Camera: Topcon TRC-NW8
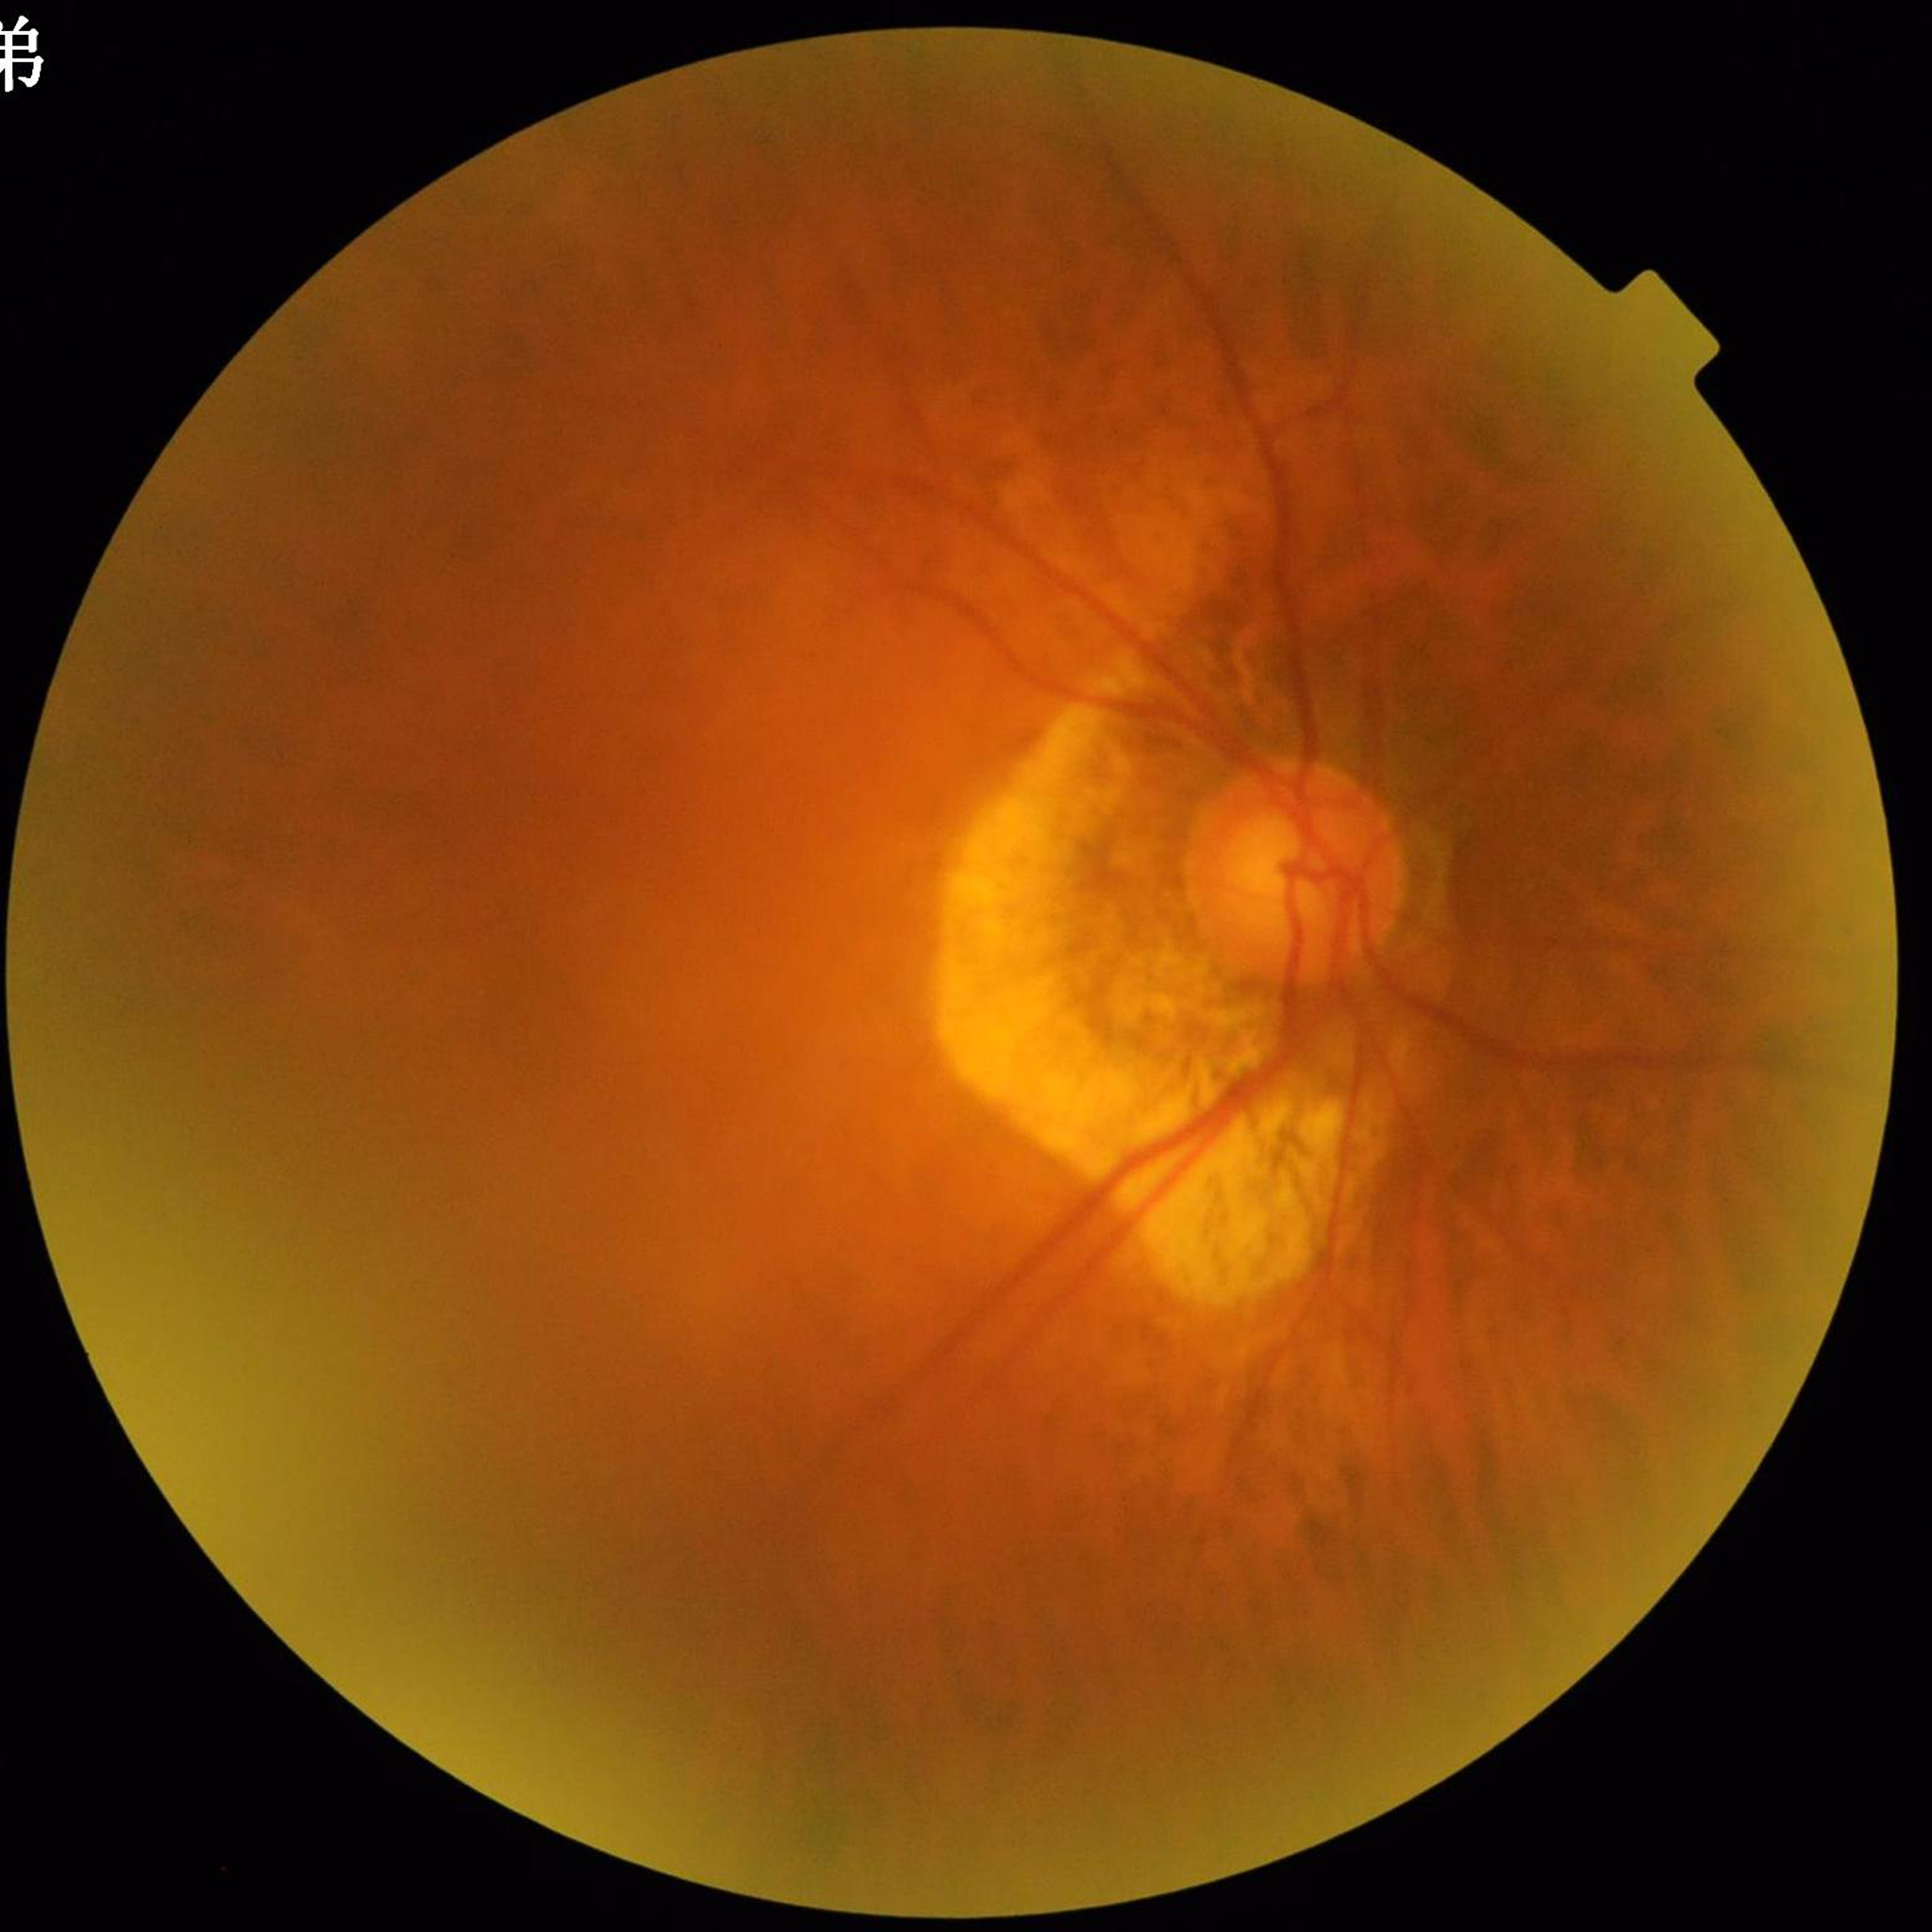

{"diagnosis": "diabetic retinopathy", "image_quality": "concerns include blur, illumination/color distortion"}